45 degree fundus photograph; acquired with a NIDEK AFC-230 — 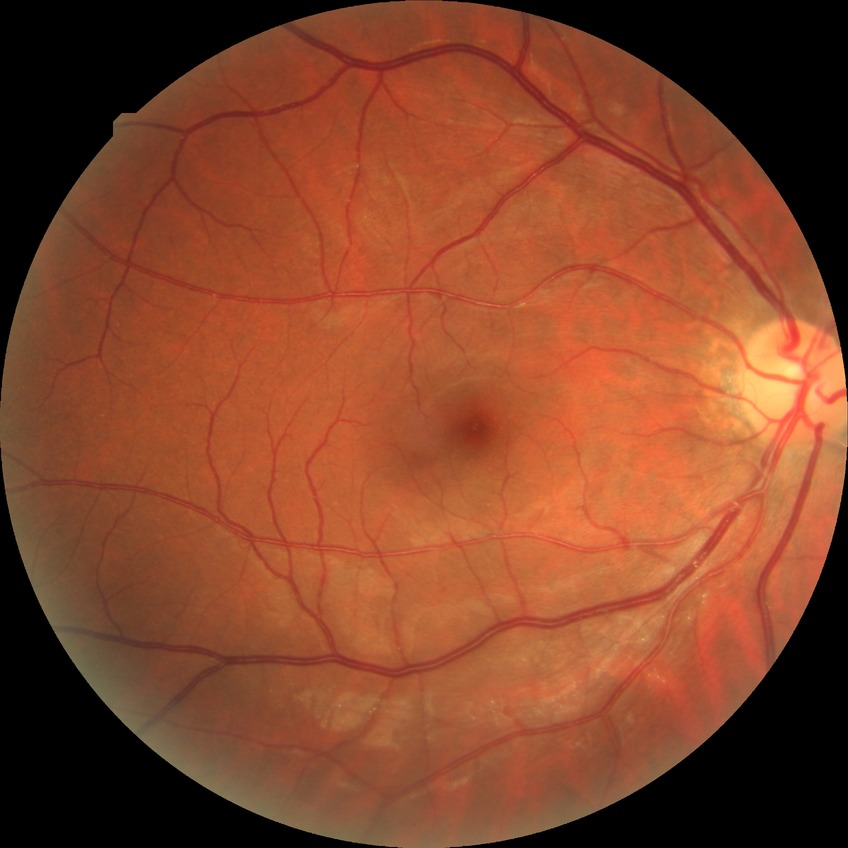
Annotations:
– diabetic retinopathy (DR) — simple diabetic retinopathy (SDR)